45° field of view · image size 2212x1659 · CFP — 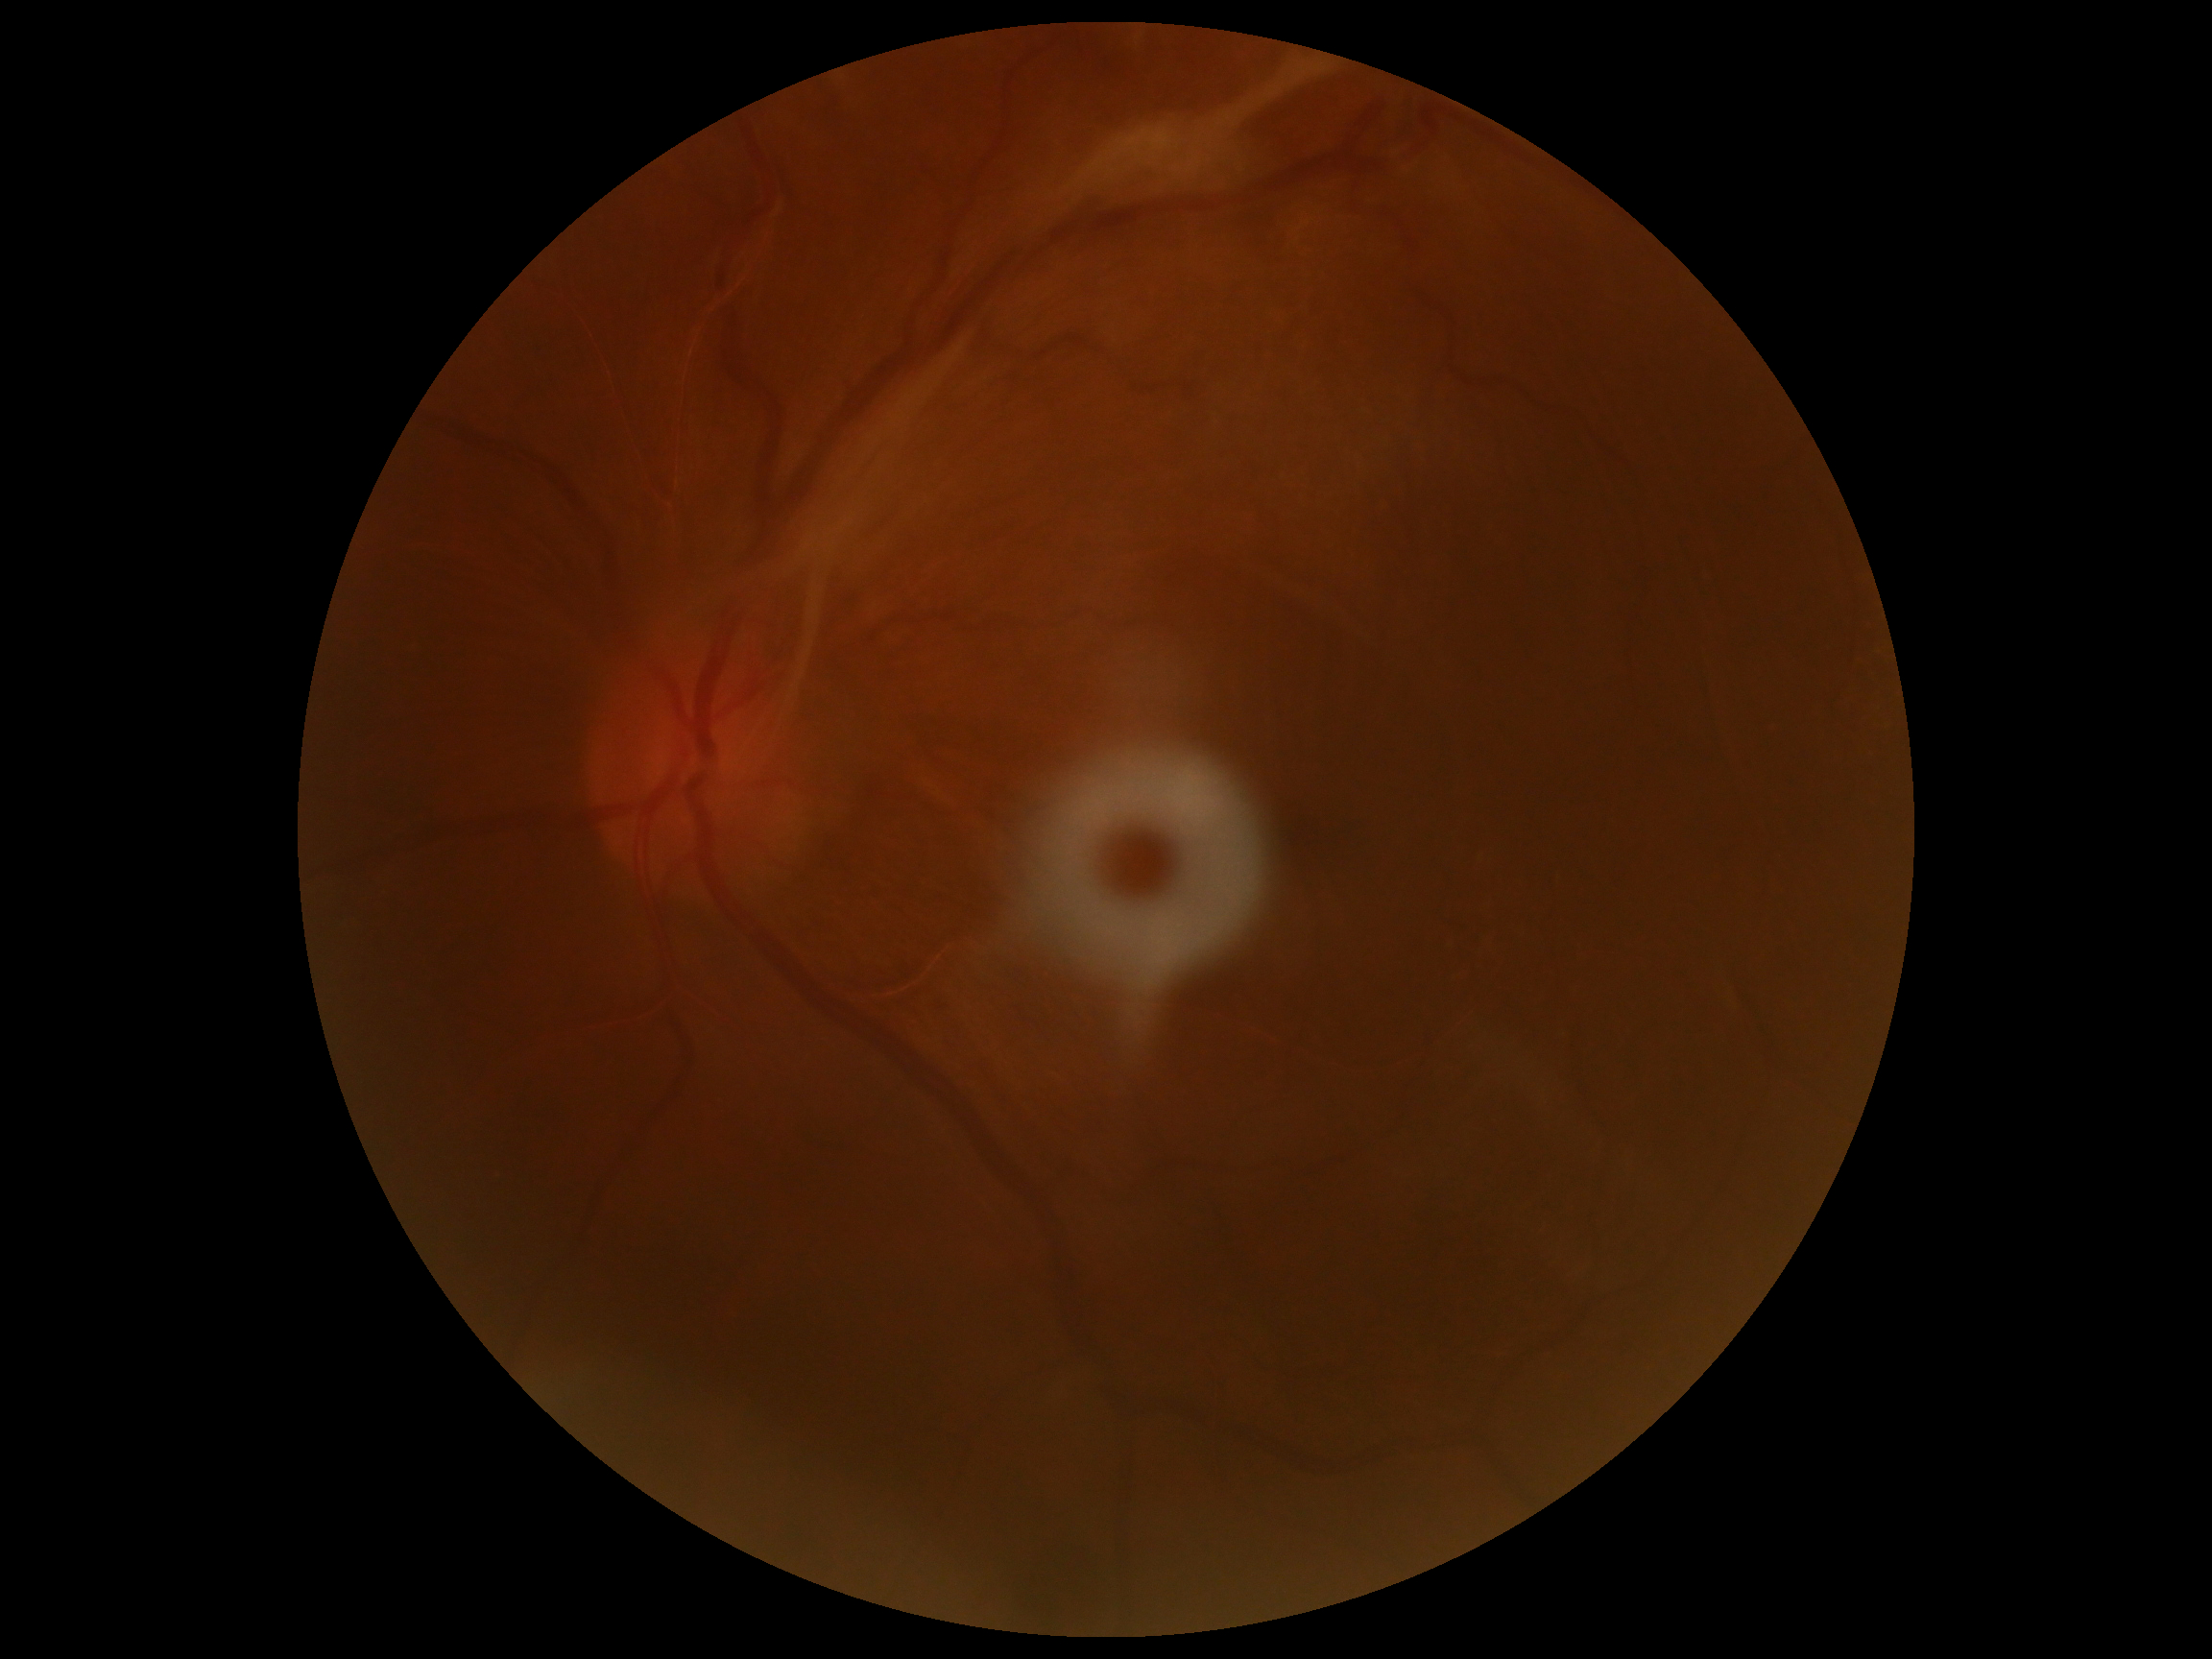

{
  "dr_grade": "4/4"
}